Davis DR grading: 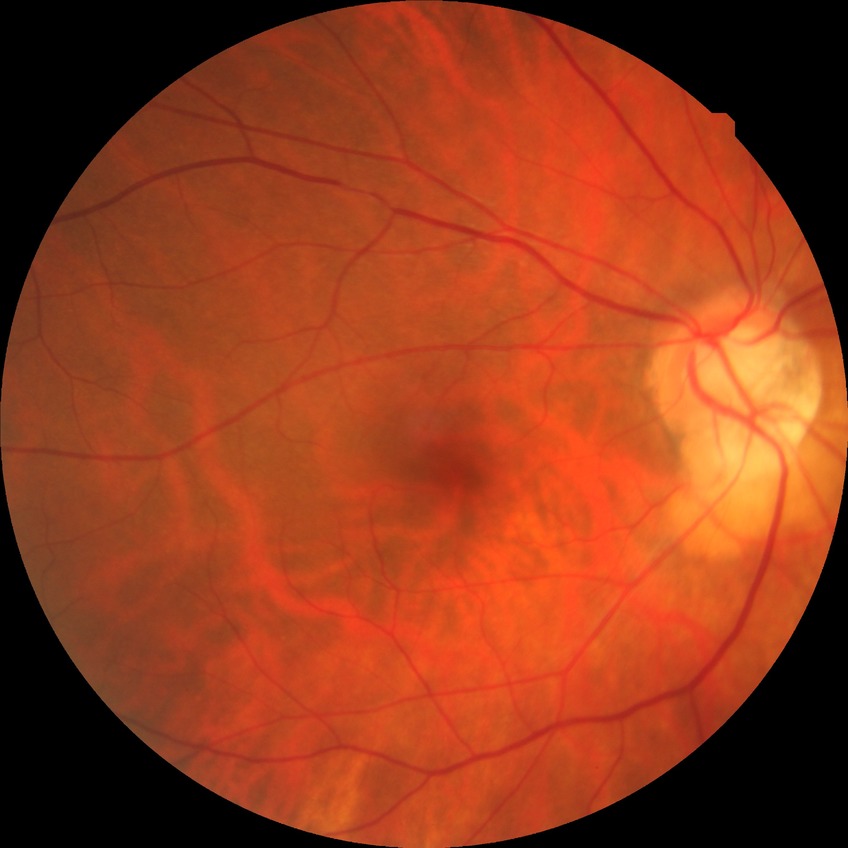
diabetic retinopathy (DR): NDR (no diabetic retinopathy).